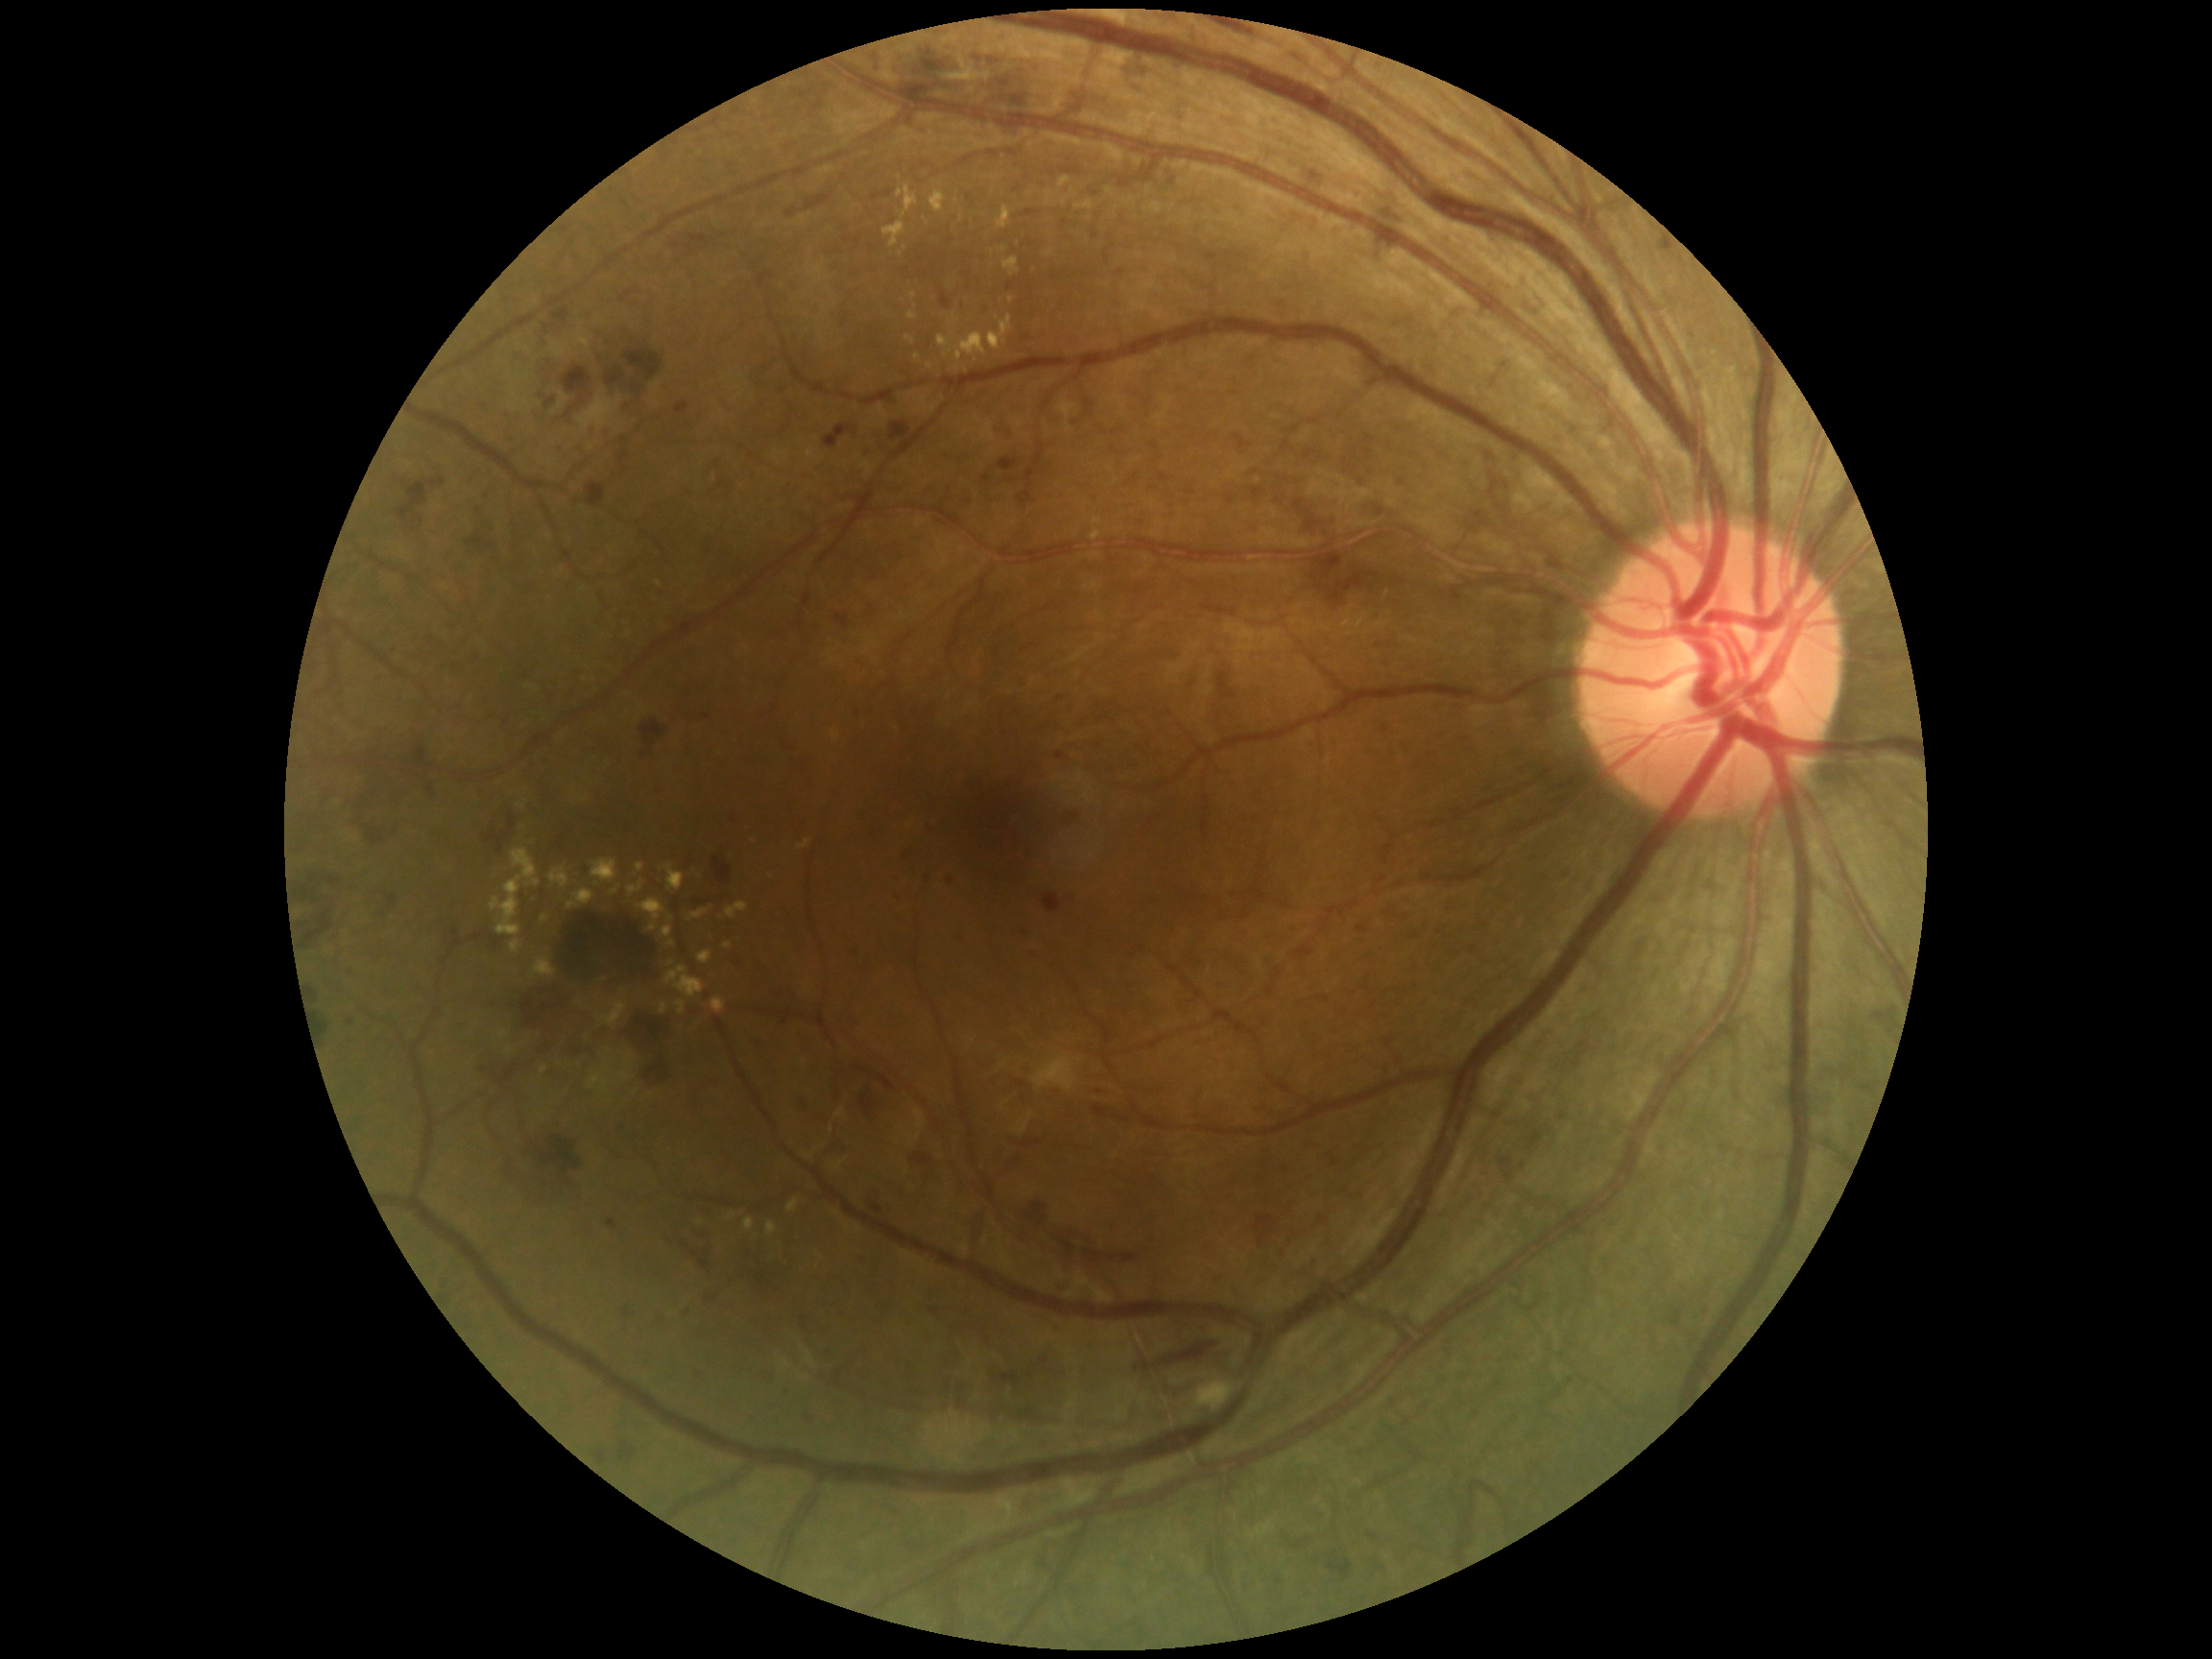
Retinopathy grade: 3 (severe NPDR); non-proliferative diabetic retinopathy
A subset of detected lesions:
- hard exudates (more not shown): x1=550, y1=868, x2=571, y2=889, x1=661, y1=865, x2=685, y2=892, x1=690, y1=909, x2=709, y2=921, x1=698, y1=951, x2=712, y2=964, x1=727, y1=903, x2=748, y2=920, x1=798, y1=841, x2=812, y2=851, x1=882, y1=222, x2=905, y2=248, x1=908, y1=312, x2=918, y2=321, x1=906, y1=336, x2=916, y2=346, x1=724, y1=944, x2=733, y2=950, x1=491, y1=849, x2=541, y2=937, x1=788, y1=1200, x2=799, y2=1214, x1=518, y1=801, x2=529, y2=811, x1=637, y1=899, x2=665, y2=932
- Smaller hard exudates around [918, 358], [597, 884], [771, 877], [1004, 249], [670, 919]
- soft exudates: x1=1032, y1=1052, x2=1077, y2=1093, x1=1194, y1=1381, x2=1236, y2=1412
- microaneurysms (more not shown): x1=960, y1=930, x2=966, y2=940, x1=1159, y1=474, x2=1168, y2=483, x1=860, y1=1255, x2=867, y2=1263, x1=605, y1=389, x2=616, y2=397, x1=804, y1=1414, x2=813, y2=1422, x1=1276, y1=1579, x2=1284, y2=1586, x1=676, y1=402, x2=690, y2=415, x1=944, y1=453, x2=953, y2=458
- Smaller microaneurysms around [999, 429], [698, 1376], [906, 858], [476, 660], [1219, 1277], [545, 759], [733, 820], [1402, 483], [951, 882], [487, 495], [706, 716], [560, 448]
- hemorrhages (more not shown): x1=823, y1=424, x2=856, y2=448, x1=607, y1=369, x2=626, y2=386, x1=621, y1=1001, x2=669, y2=1066, x1=548, y1=908, x2=661, y2=994, x1=1255, y1=1216, x2=1276, y2=1247, x1=915, y1=60, x2=947, y2=76, x1=1135, y1=87, x2=1144, y2=95, x1=941, y1=293, x2=953, y2=310, x1=588, y1=484, x2=607, y2=508, x1=414, y1=746, x2=428, y2=770, x1=545, y1=398, x2=557, y2=409, x1=999, y1=1374, x2=1021, y2=1386, x1=760, y1=1369, x2=777, y2=1386, x1=793, y1=1095, x2=813, y2=1116, x1=786, y1=207, x2=799, y2=219, x1=1311, y1=572, x2=1381, y2=605, x1=397, y1=482, x2=428, y2=524, x1=479, y1=1056, x2=515, y2=1087
- Smaller hemorrhages around [929, 54]